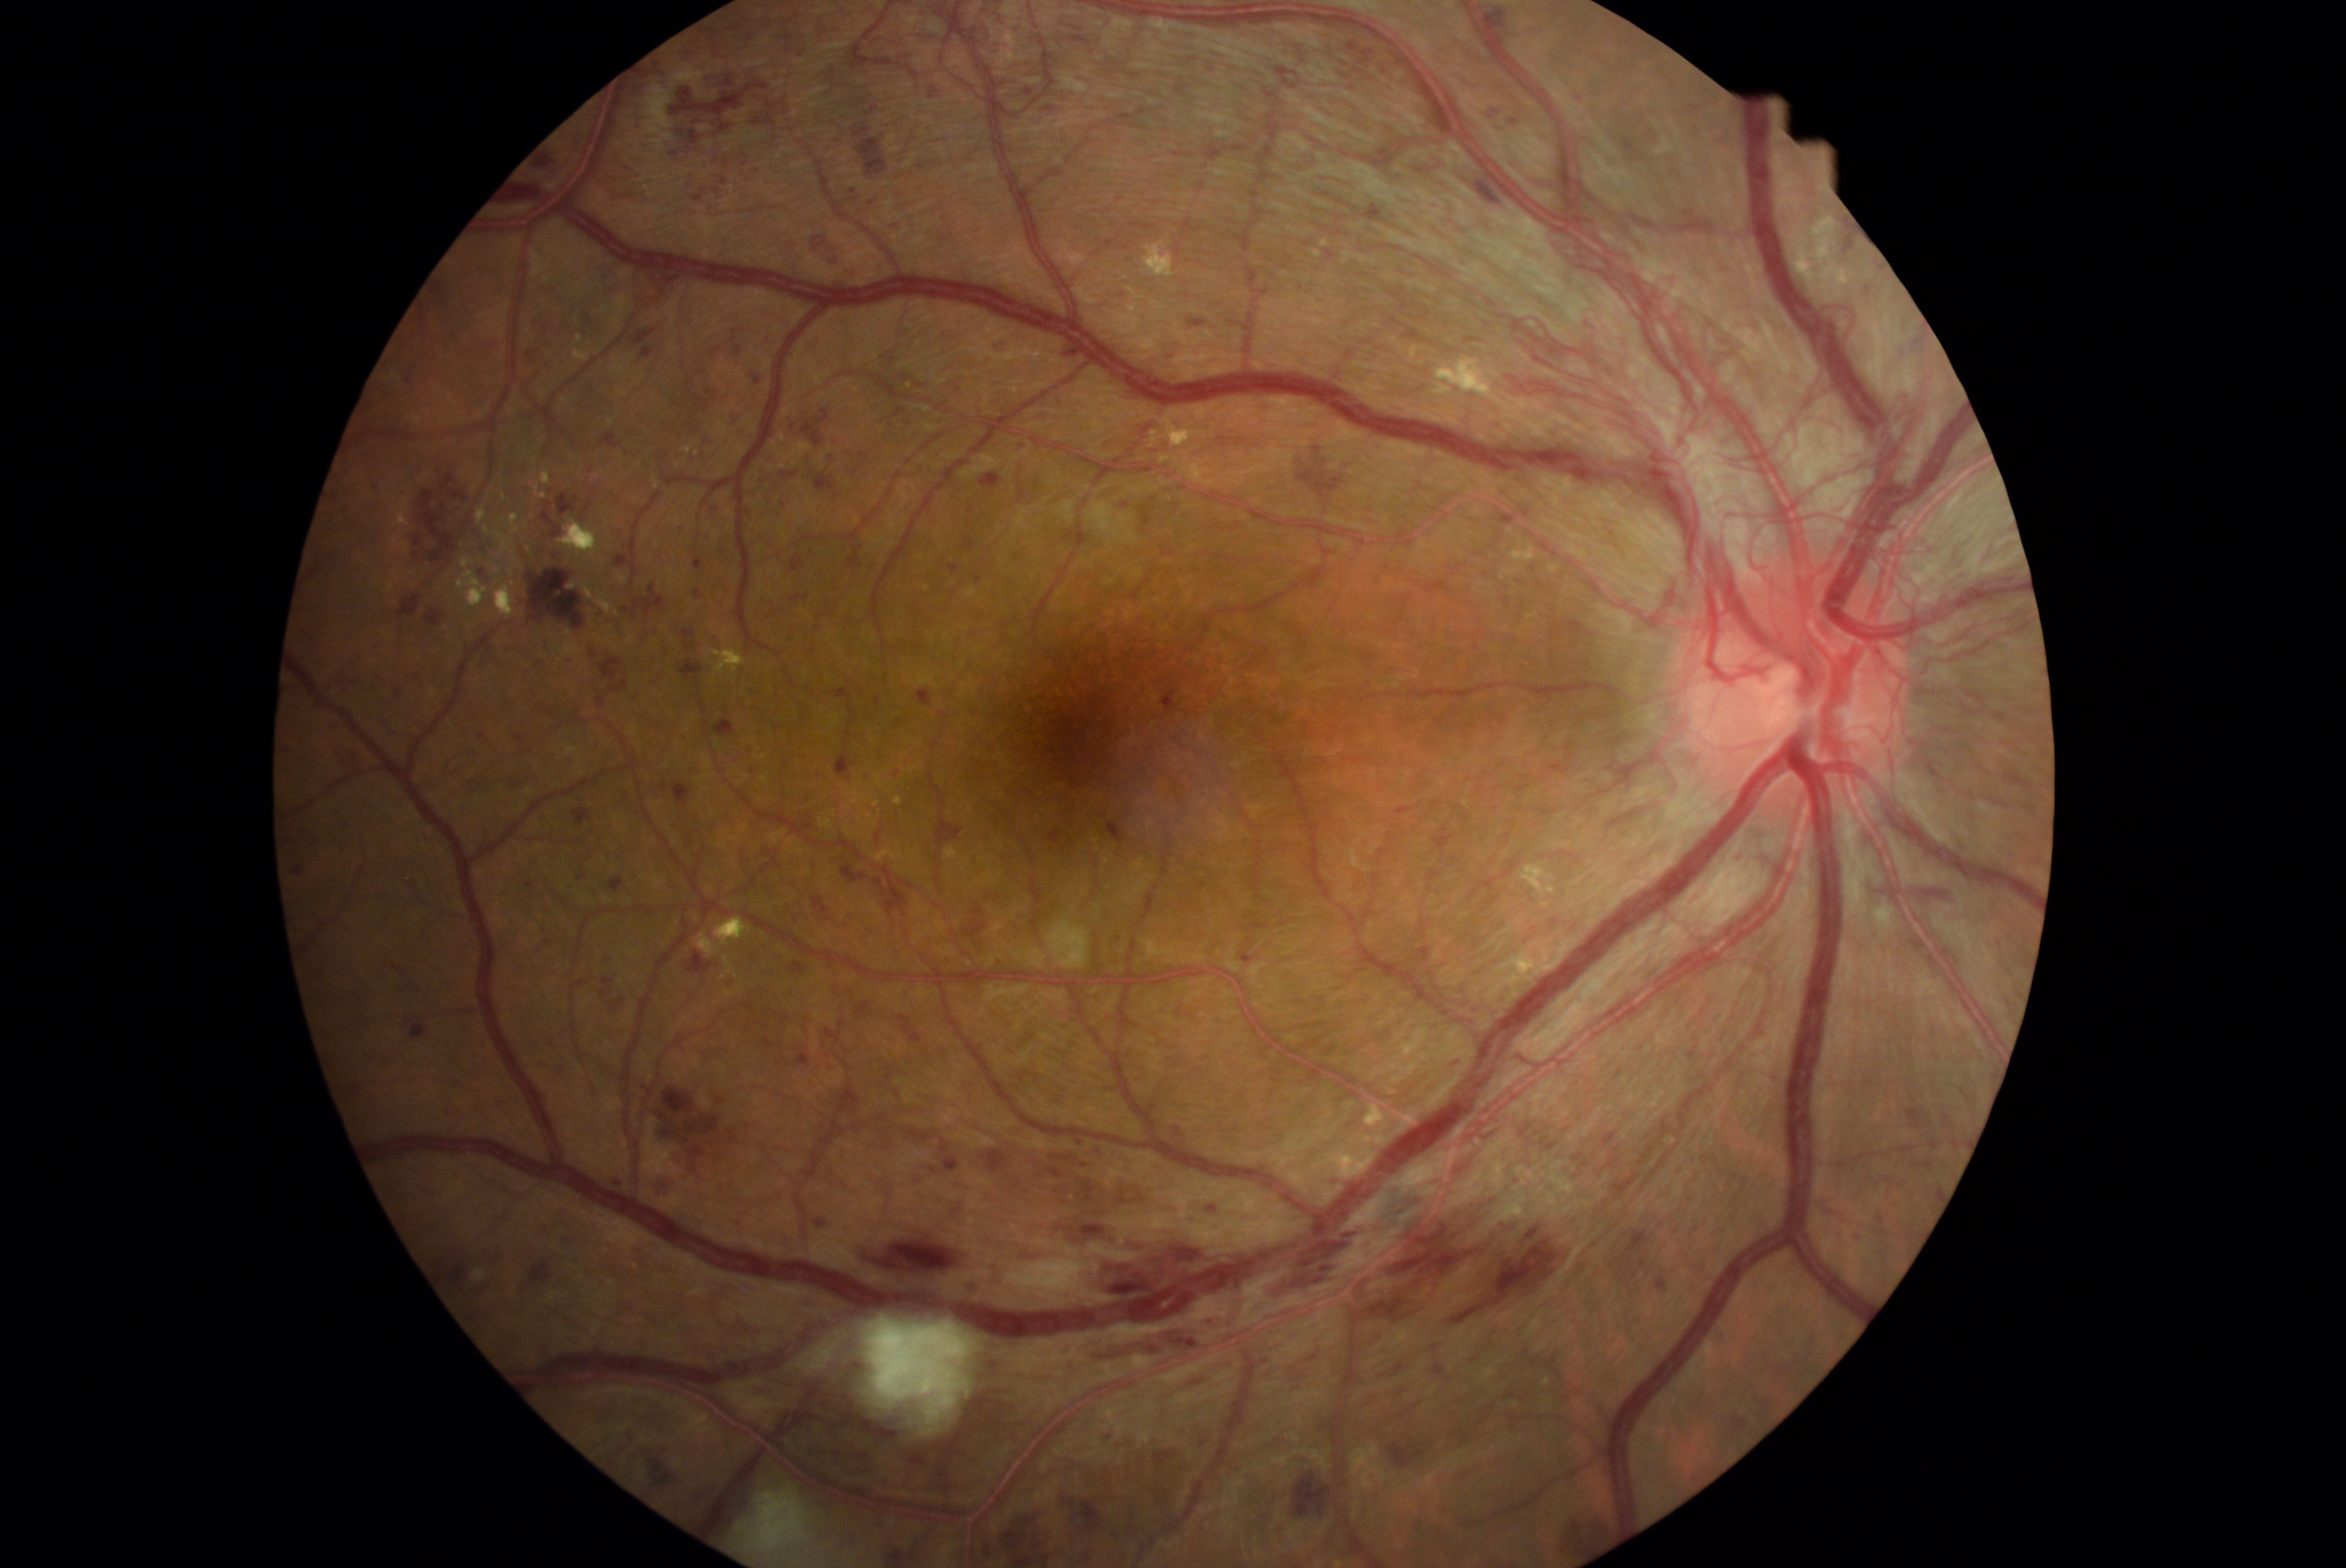 <lesions partial="true">
  <dr_grade>4</dr_grade>
  <he partial="true">1759/1399/1776/1418 | 434/1238/509/1313 | 531/1258/554/1285 | 332/720/344/731 | 623/584/666/615 | 680/659/703/680 | 874/1515/888/1531 | 815/1221/827/1227 | 1563/1506/1619/1552 | 1108/821/1125/844 | 609/877/625/893 | 760/332/769/344 | 623/1428/639/1446 | 534/1056/547/1070 | 736/346/743/355 | 1406/153/1448/175 | 1638/1258/1647/1269</he>
  <he_small_centers>Point(549, 490) | Point(898, 1095) | Point(717, 190)</he_small_centers>
</lesions>